1240x1240. Wide-field contact fundus photograph of an infant
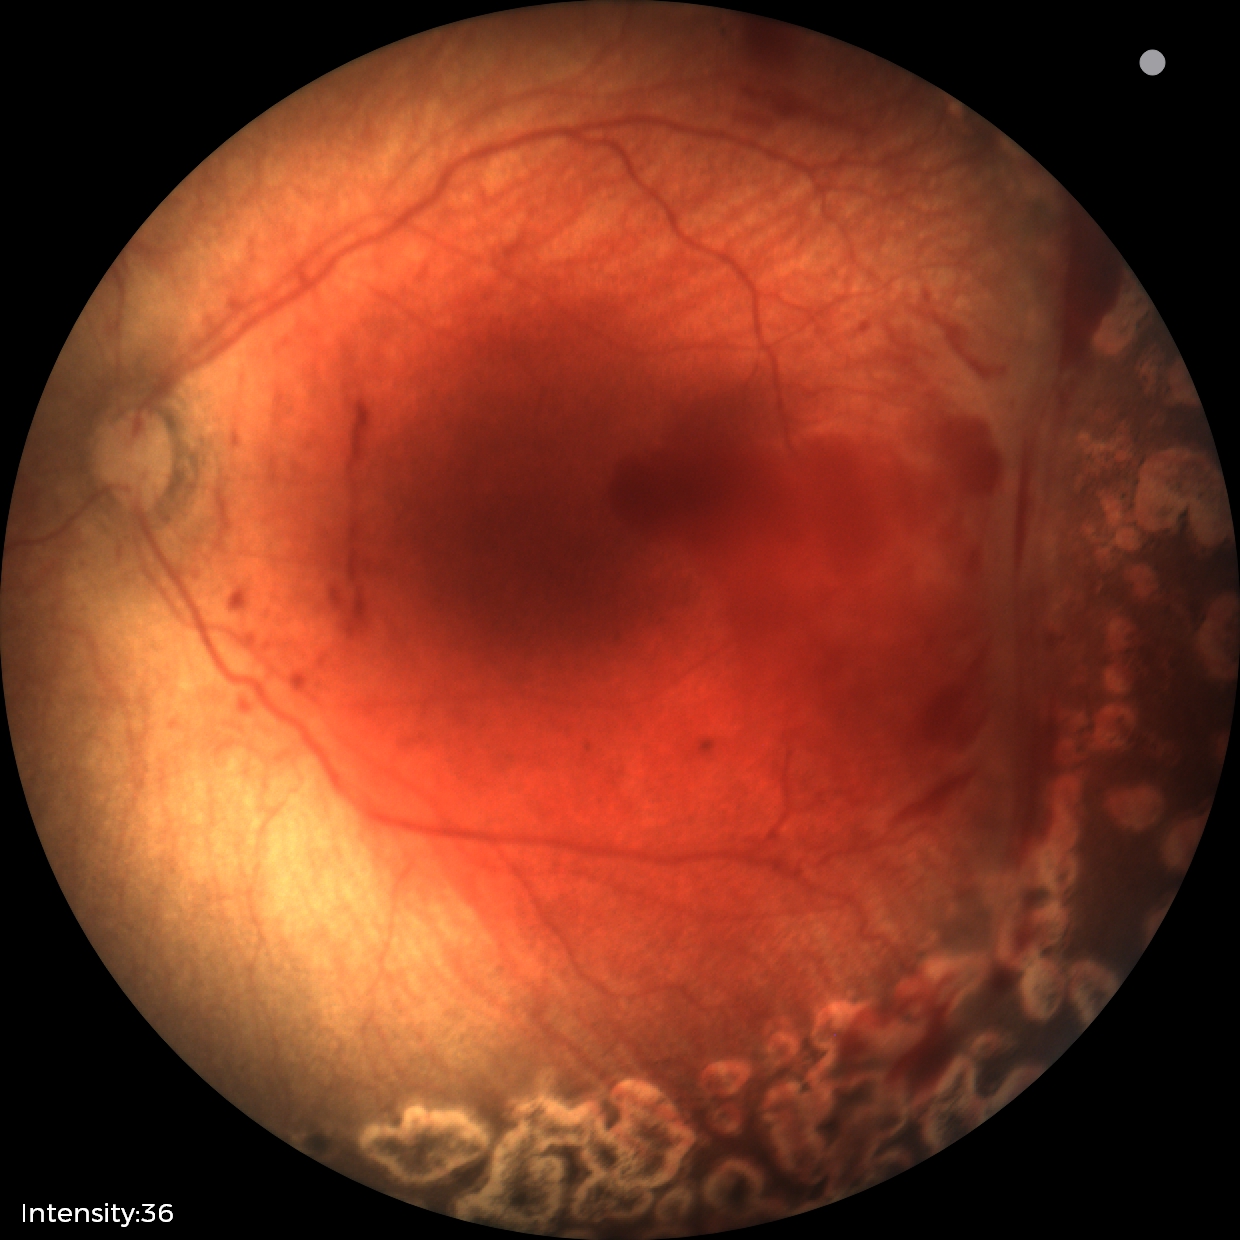
Assessment = status post ROP, plus disease = absent.